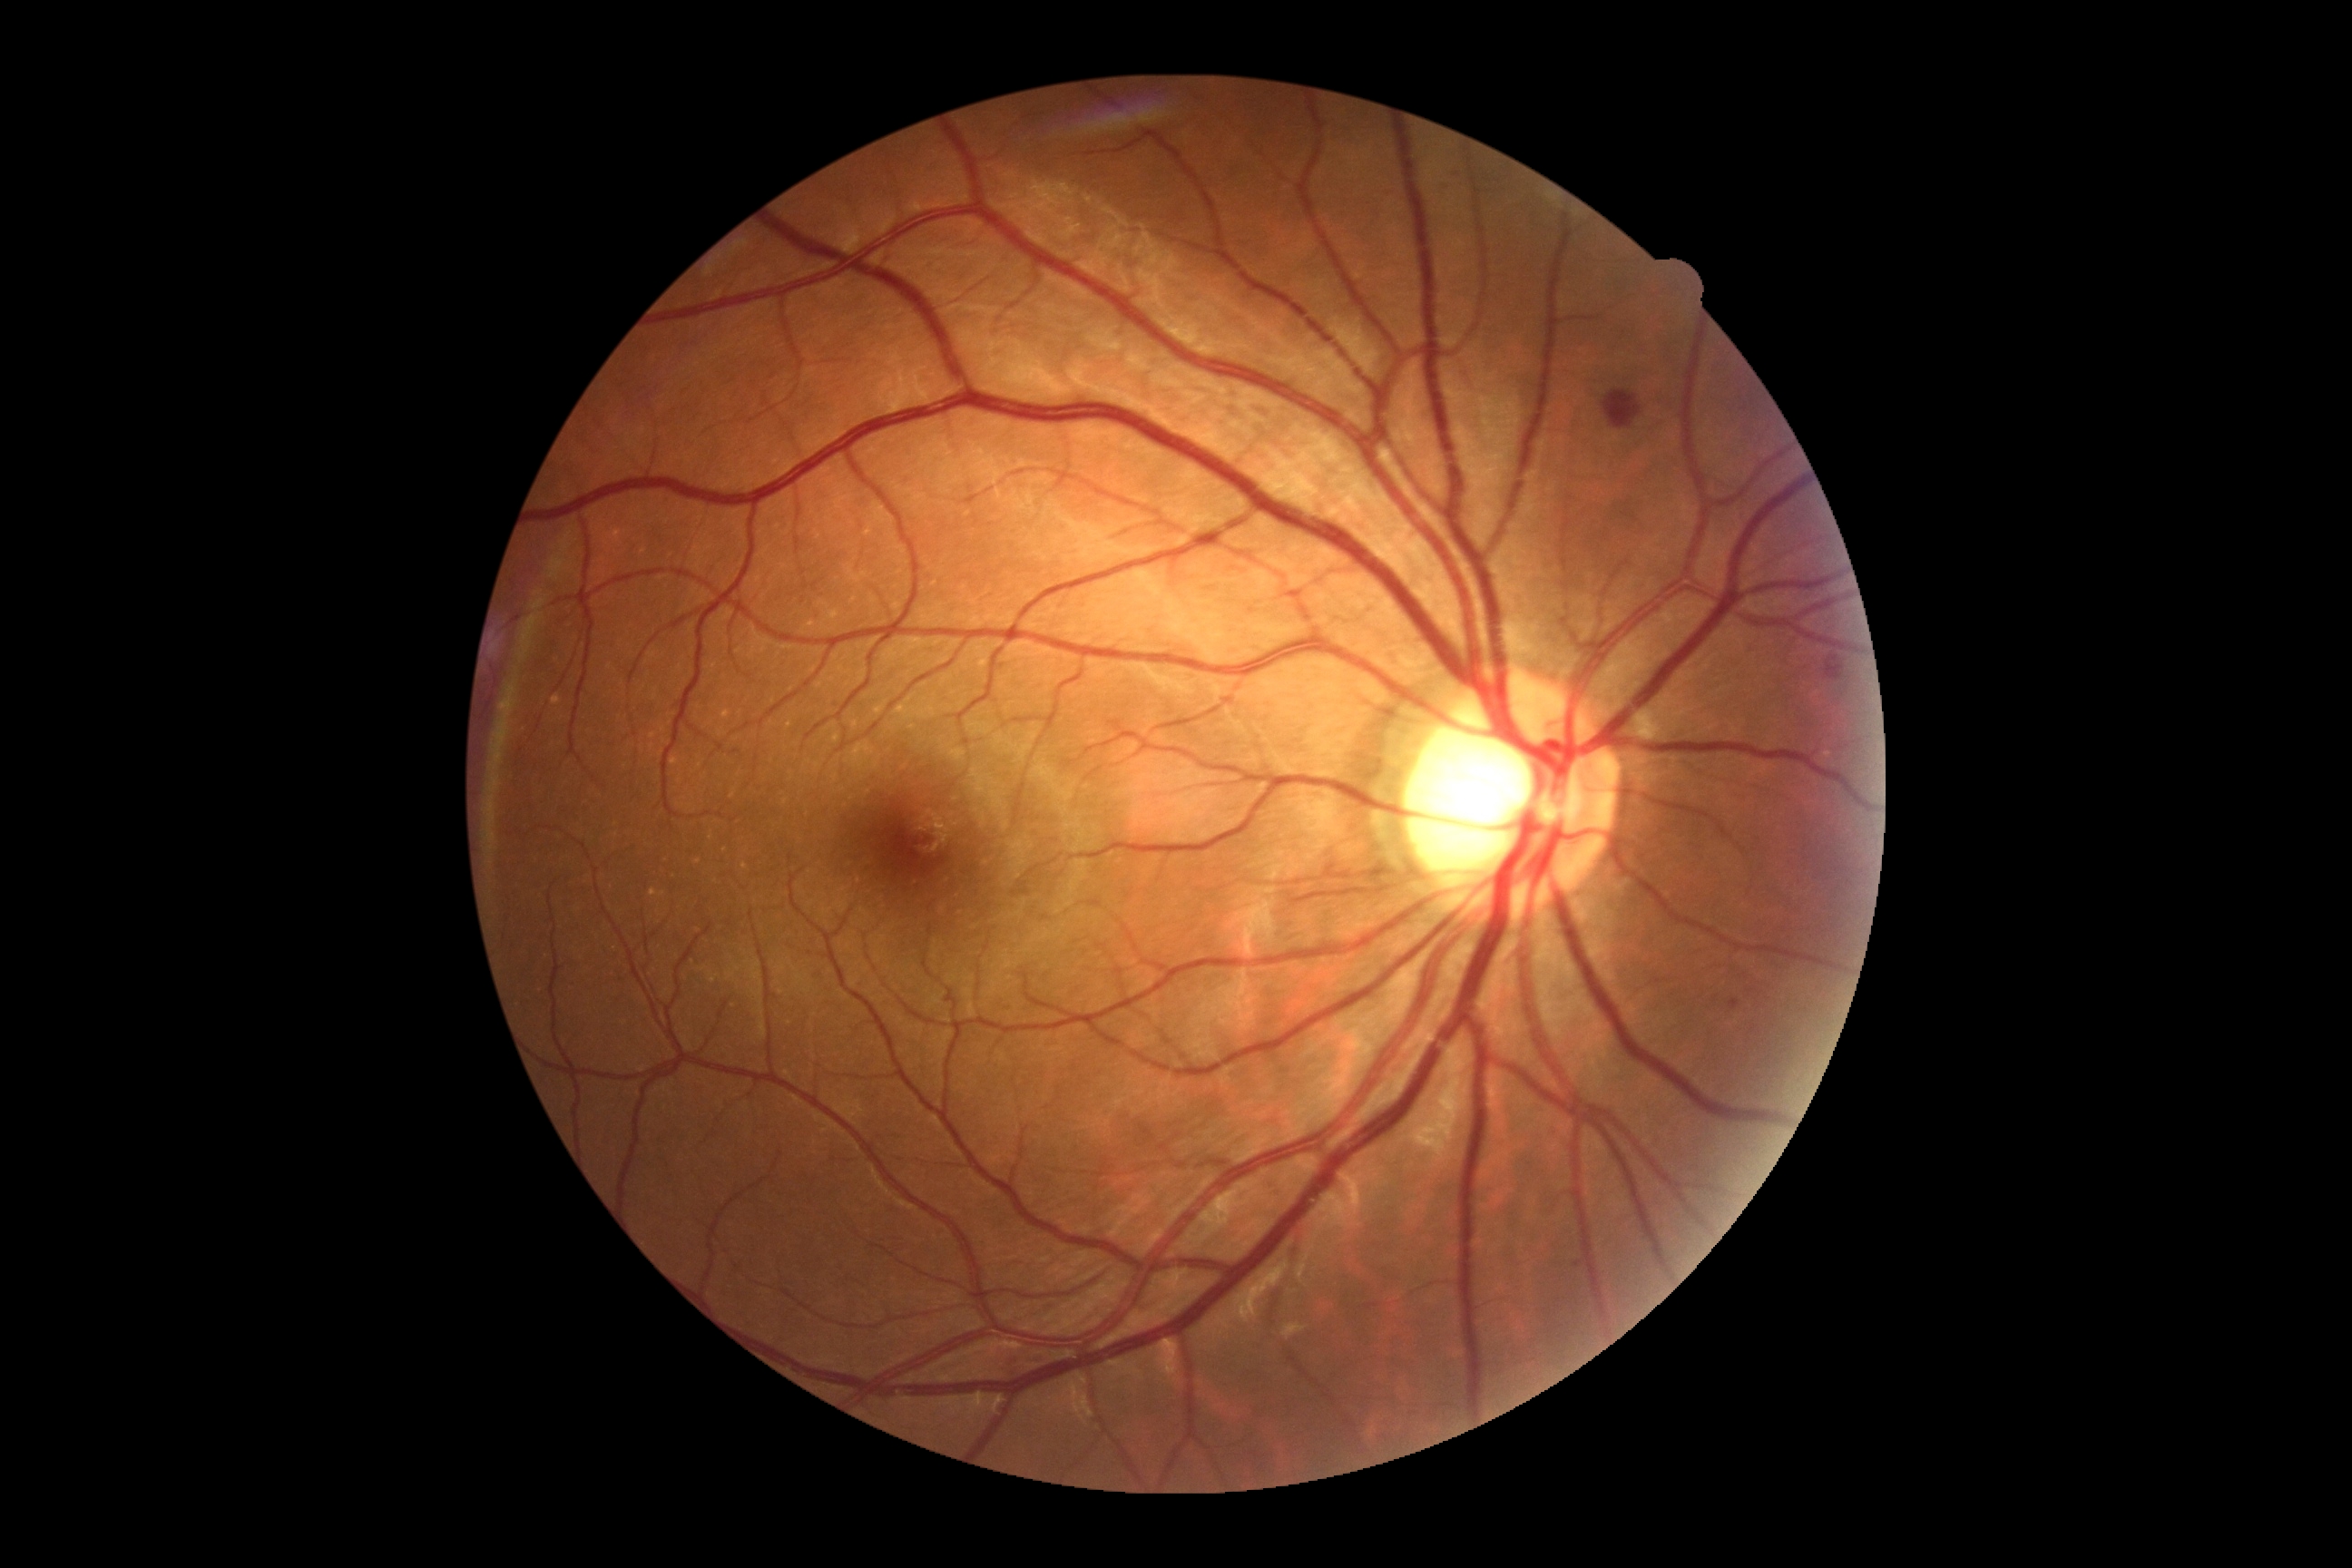 DR severity is grade 2 (moderate NPDR) — more than just microaneurysms but less than severe NPDR.